50° FOV. Retinal fundus photograph — 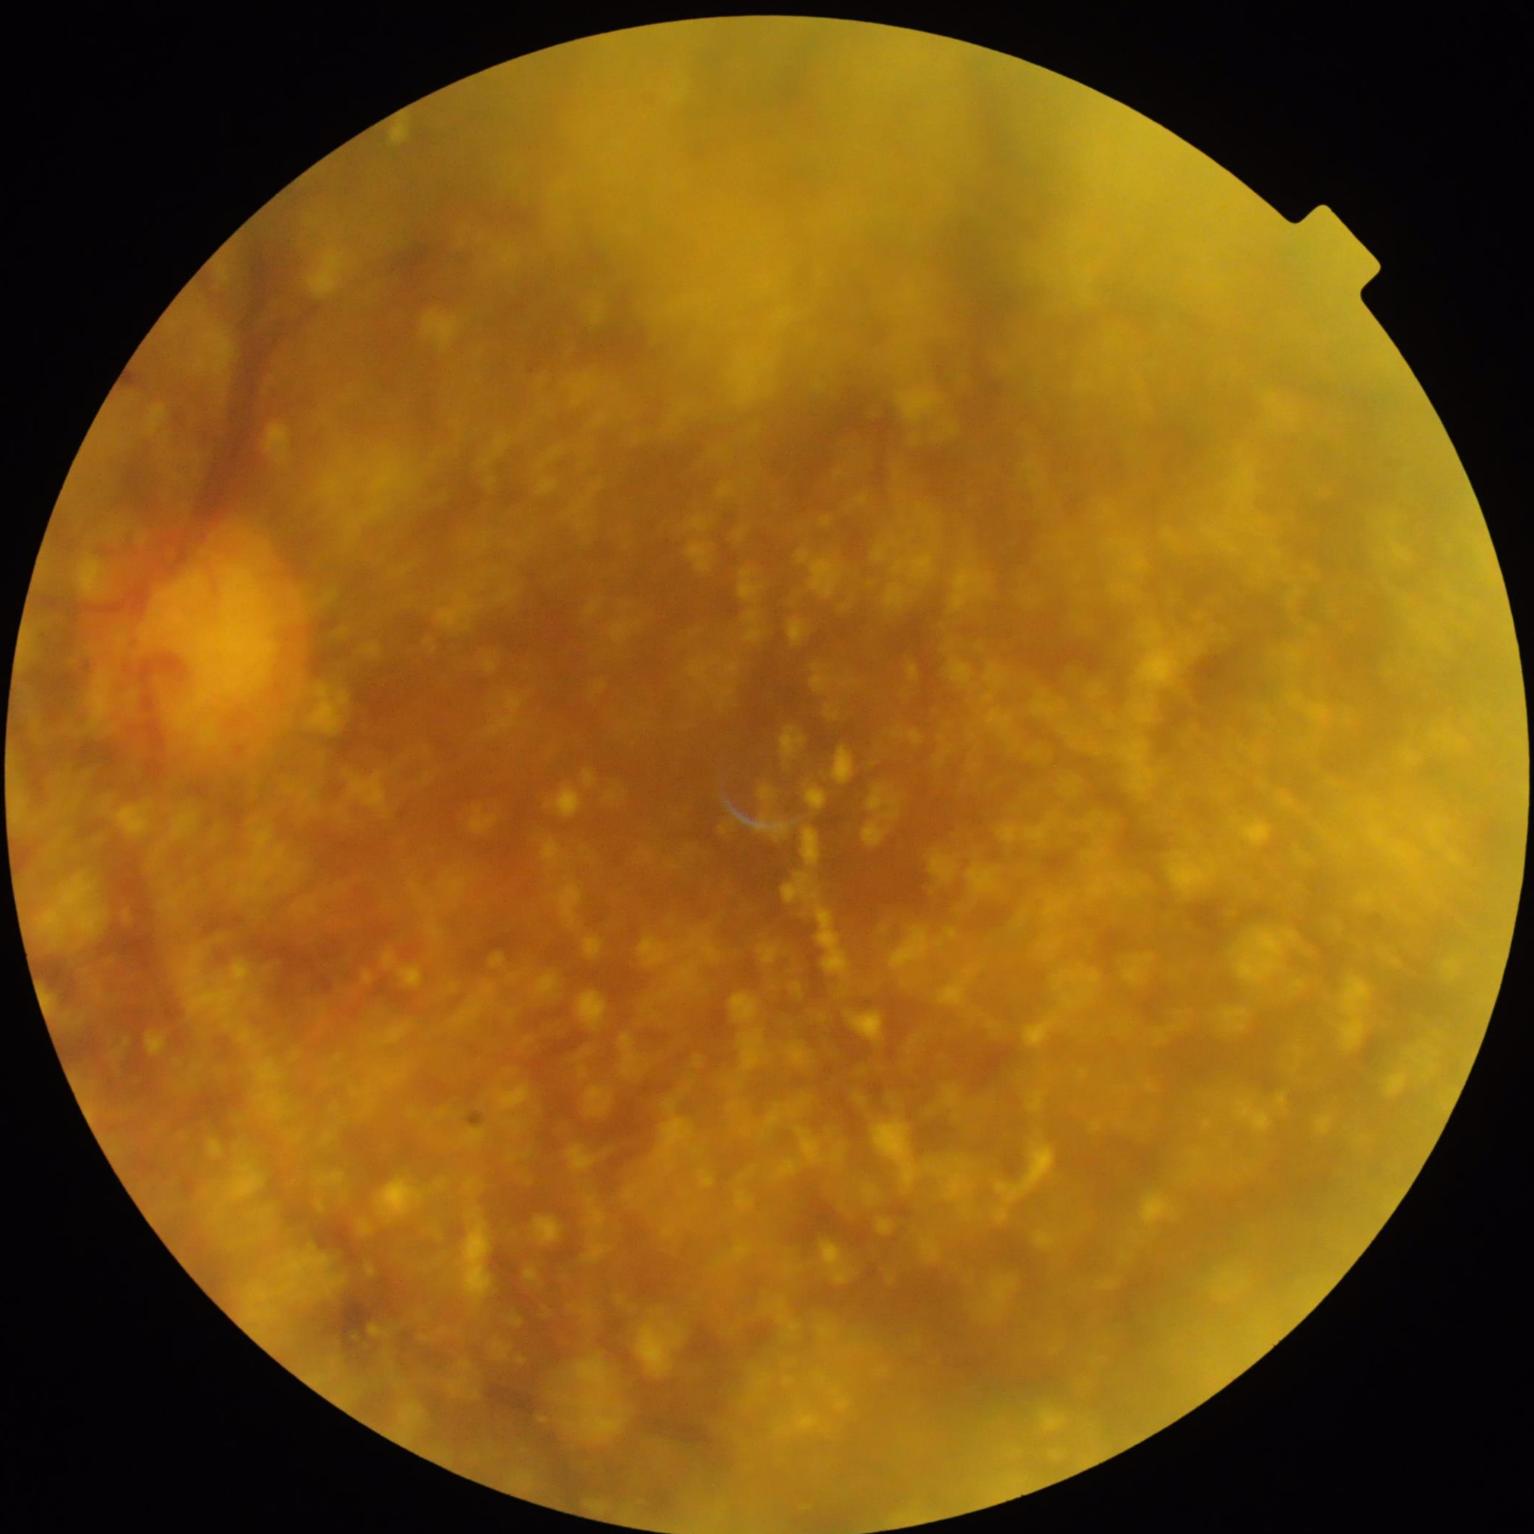
  illumination: uneven
  contrast: poor
  clarity: out of focus
  overall_quality: suboptimal